45° FOV
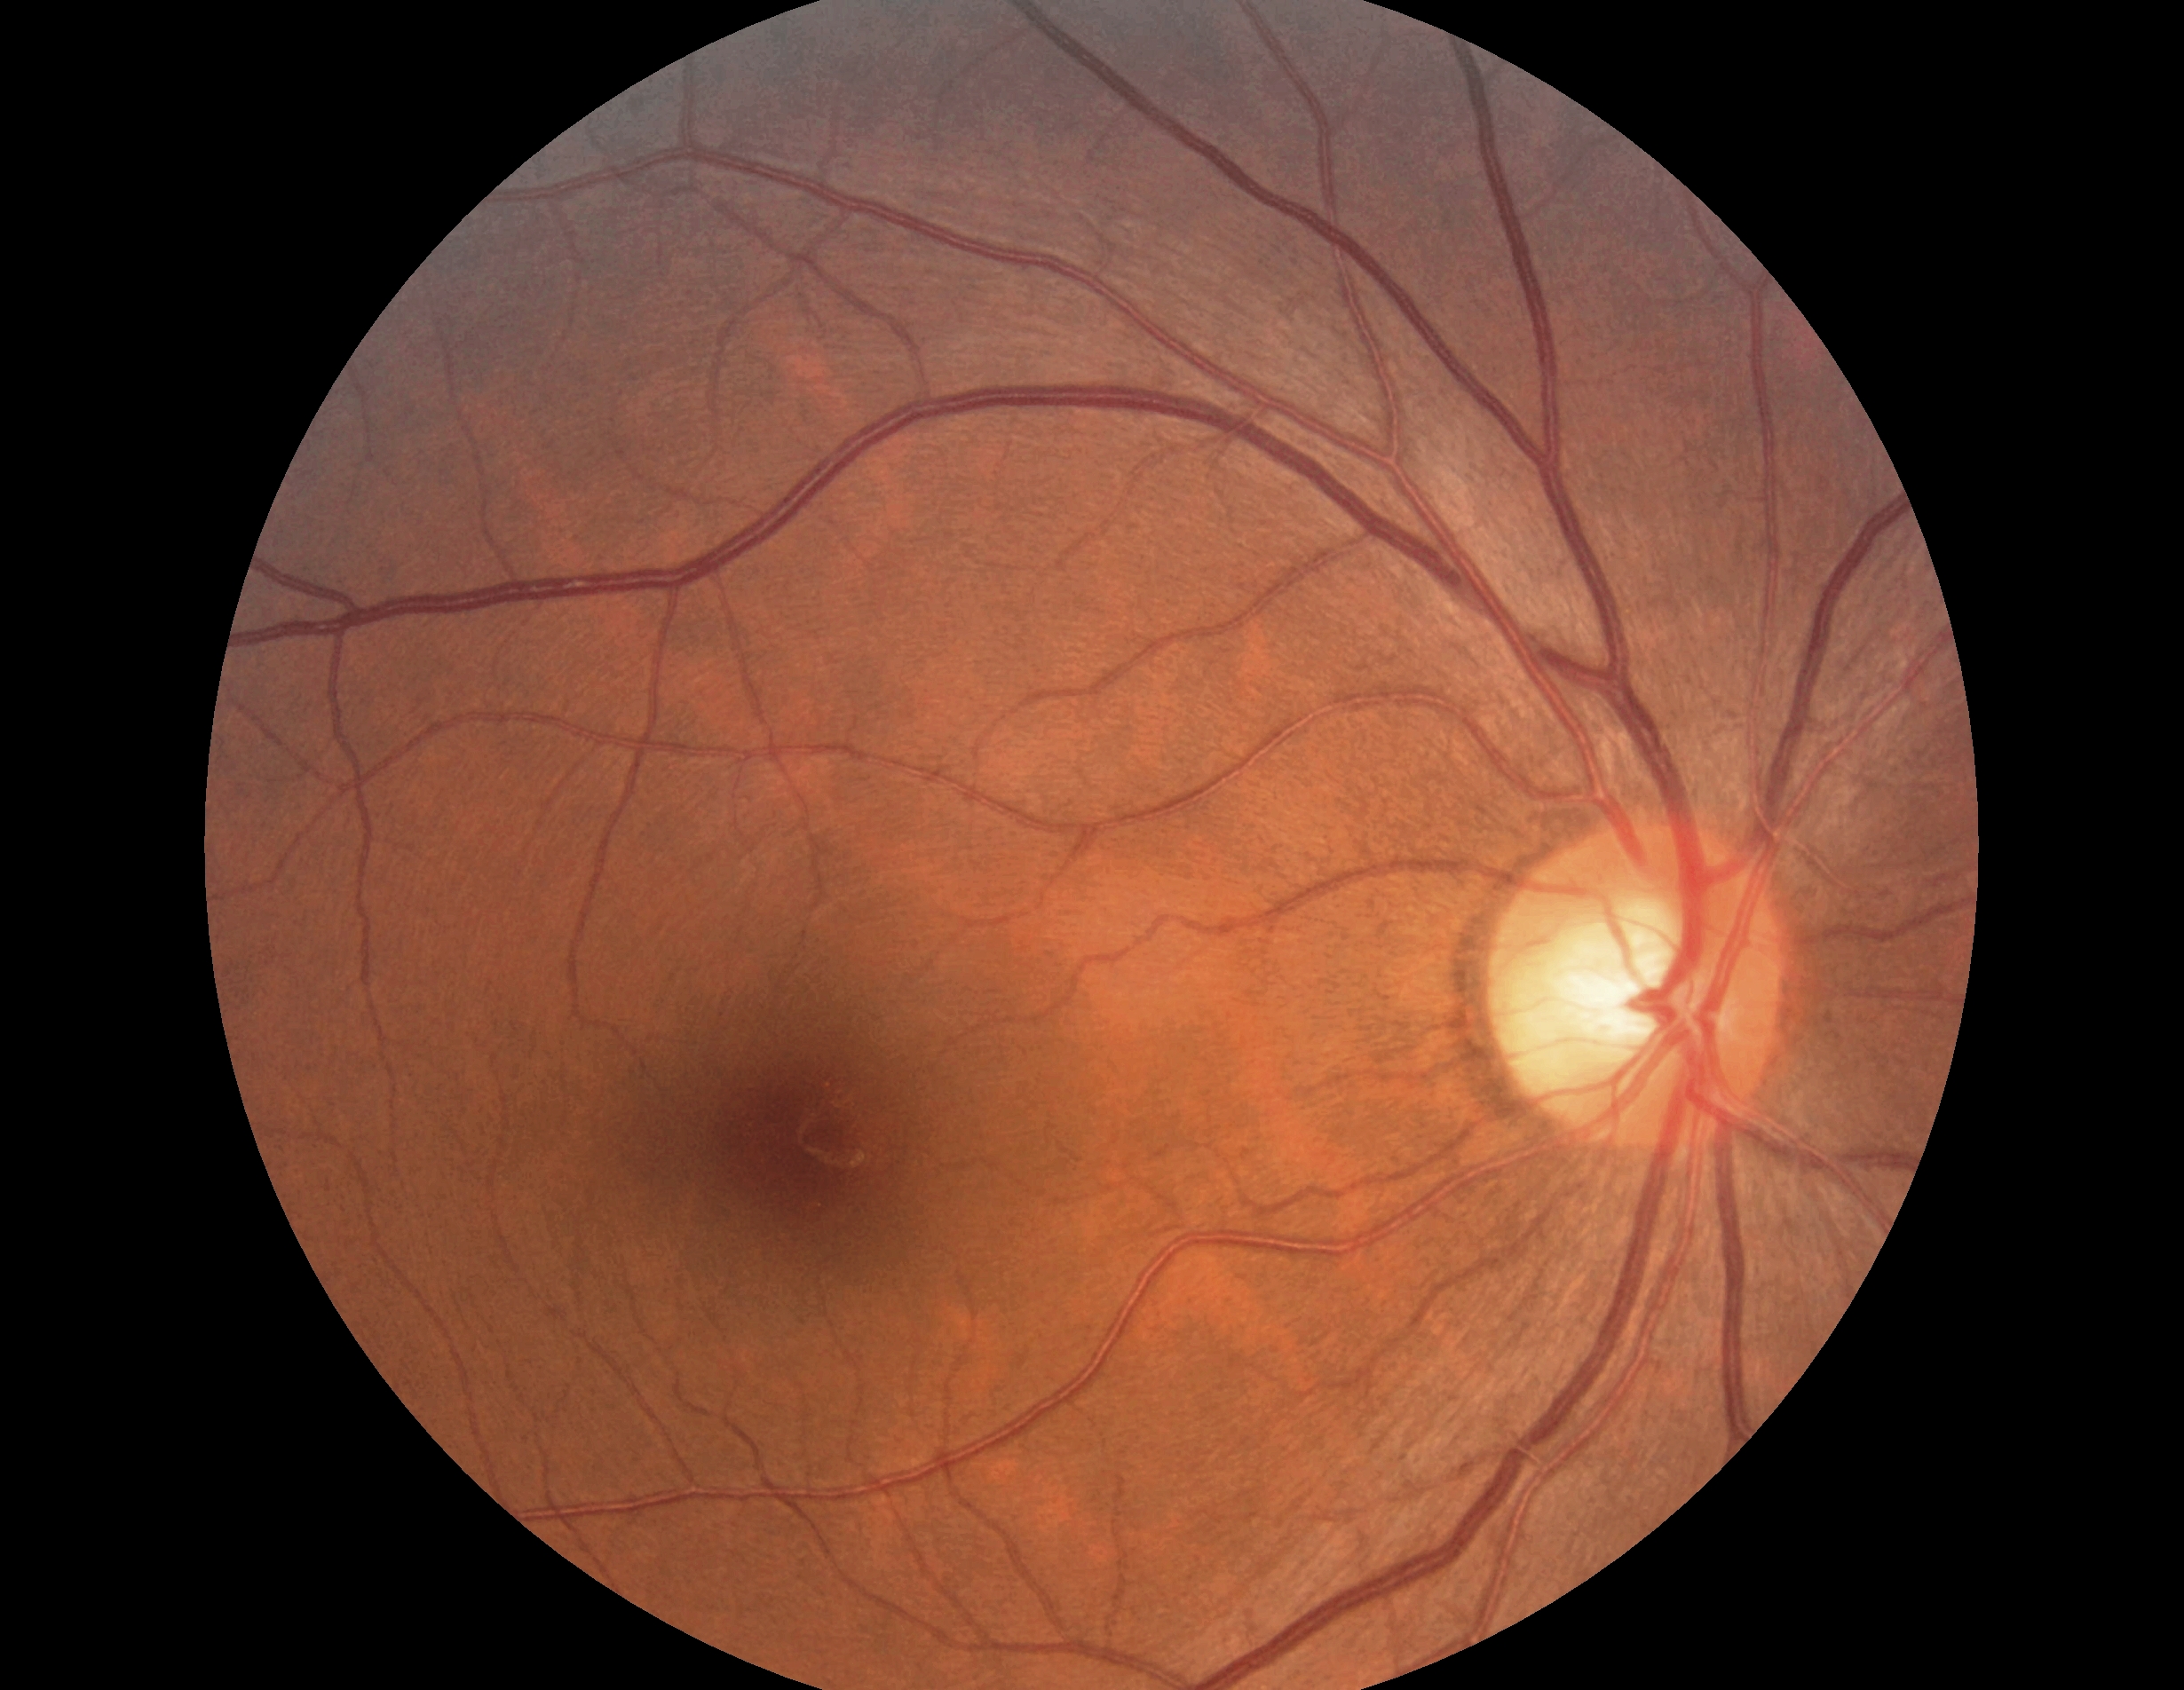

DR grade is no apparent diabetic retinopathy (0).